FOV: 50 degrees: 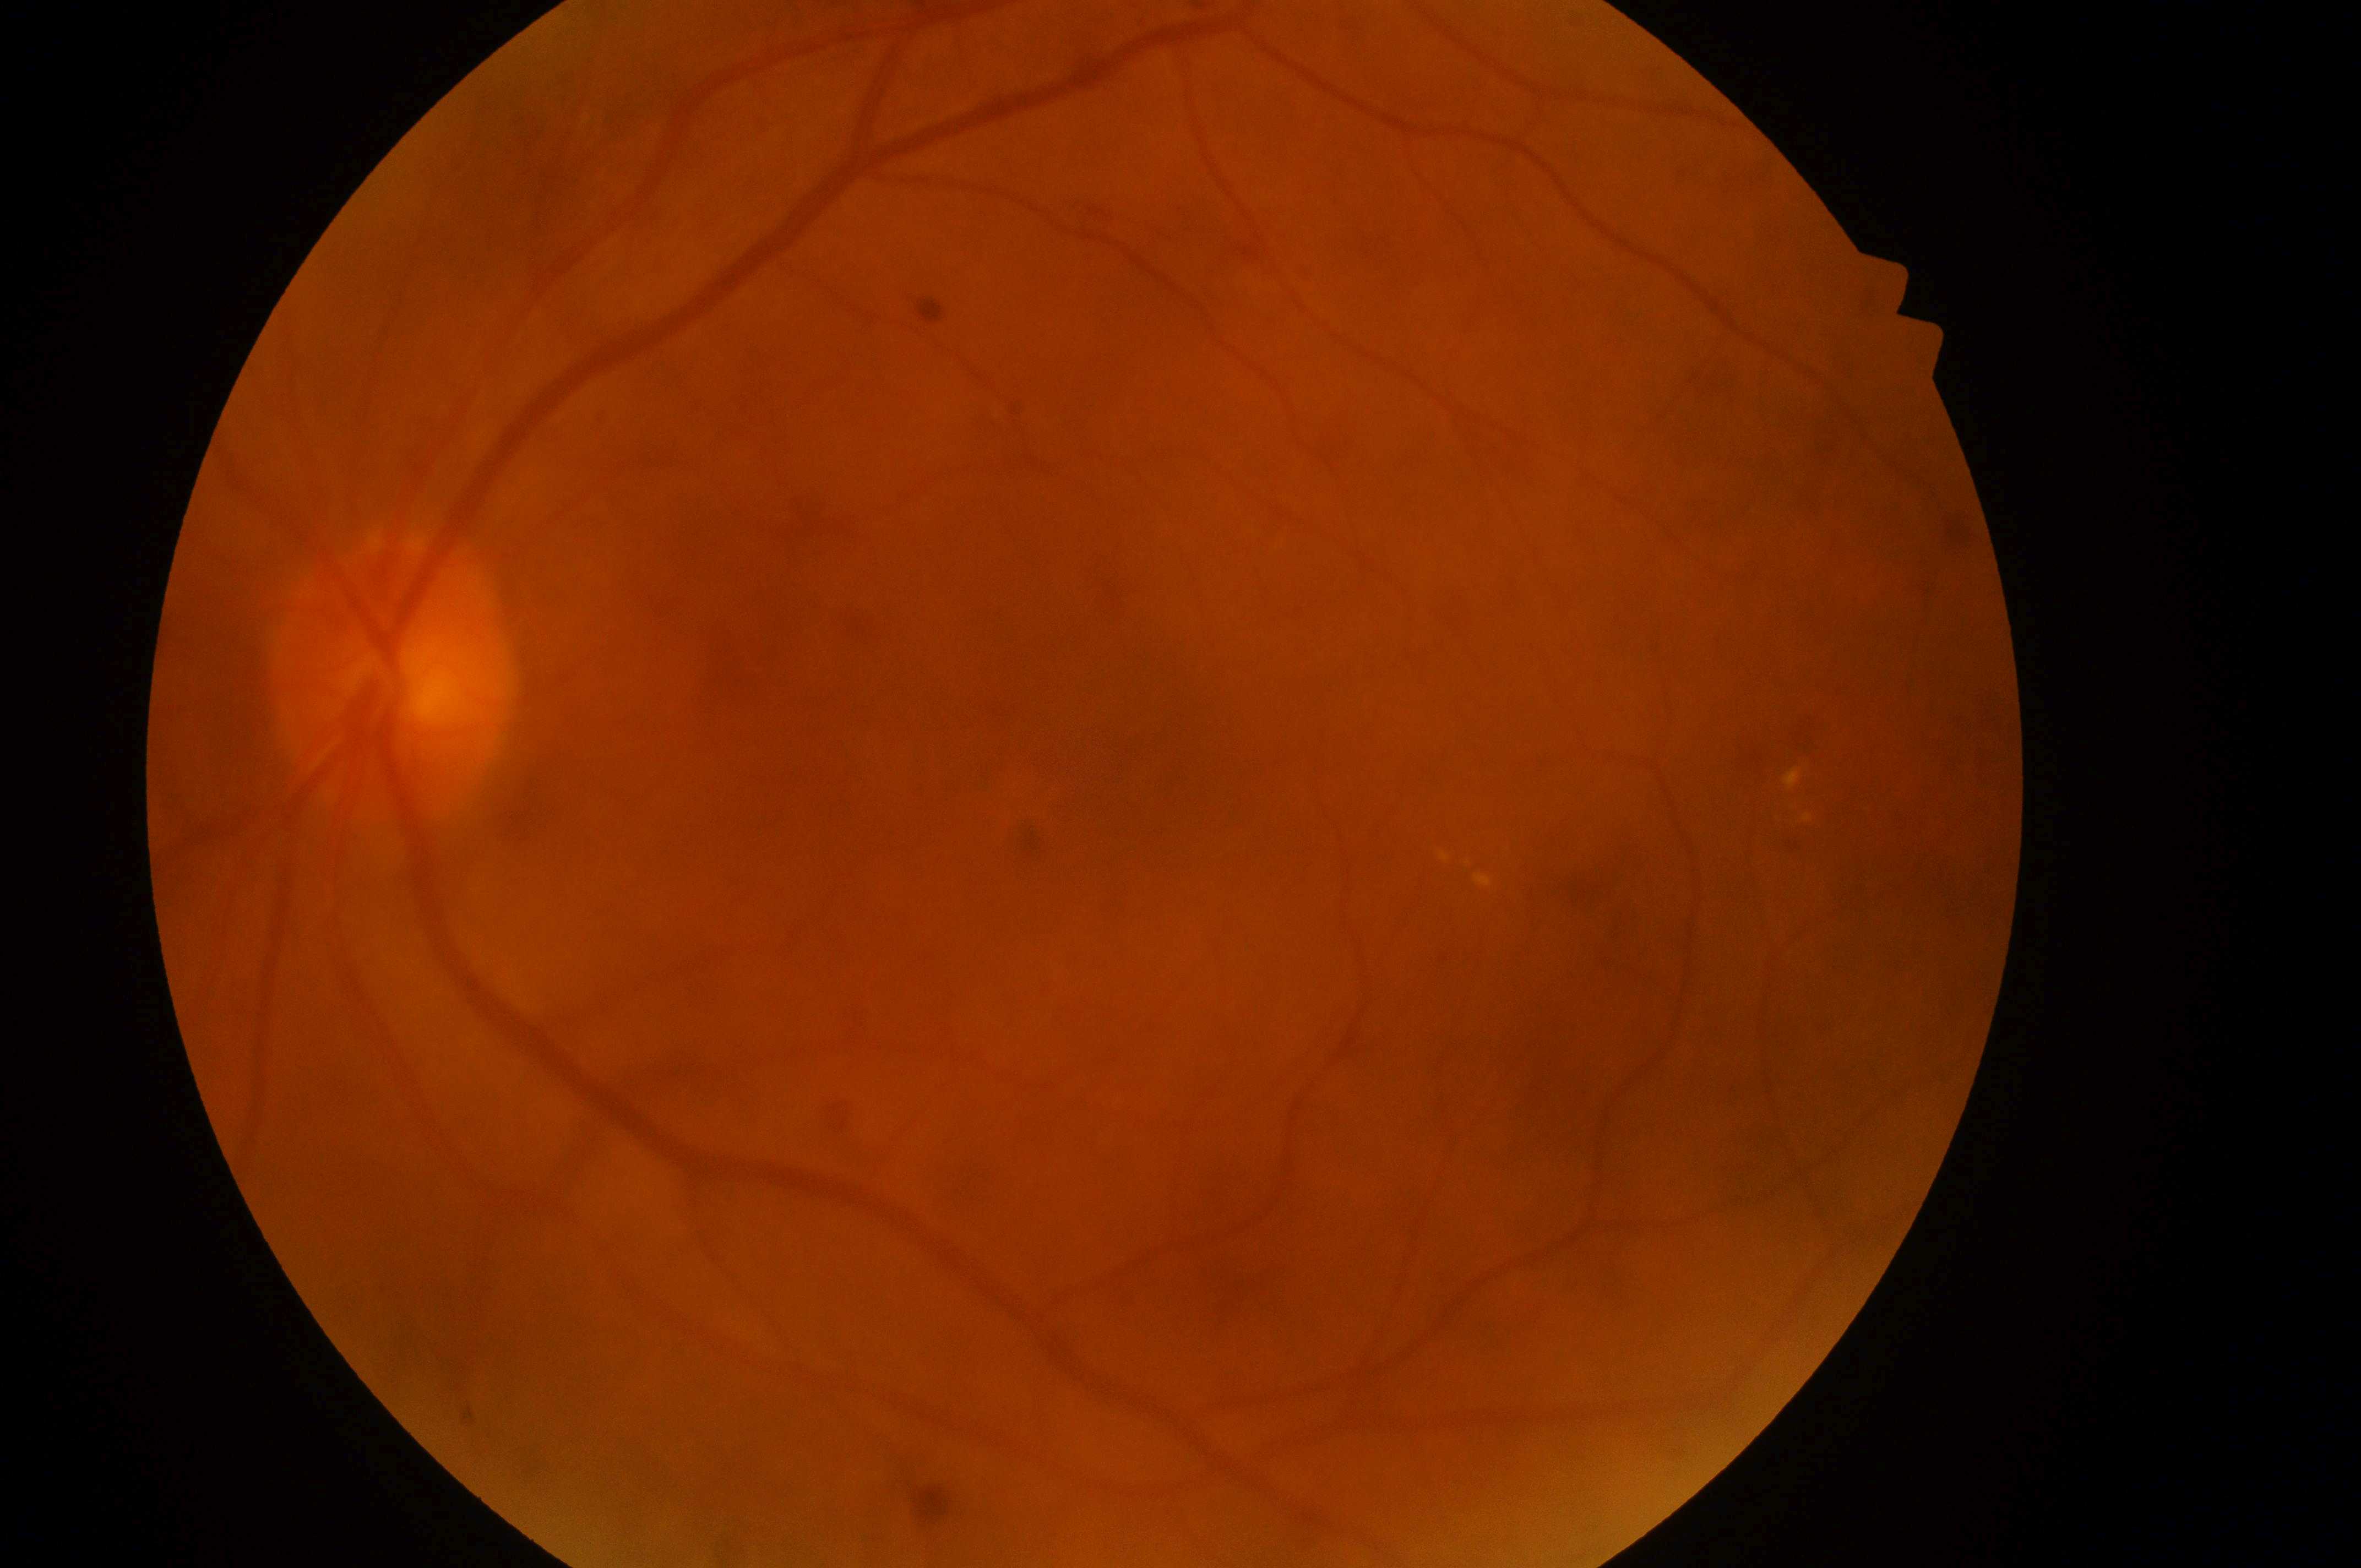

DR is moderate non-proliferative diabetic retinopathy (grade 2).
DME: low risk (grade 1).
Macular center: (x=1126, y=752).
Imaged eye: left.
The optic disc is at (x=388, y=688).